NIDEK AFC-230; DR severity per modified Davis staging — 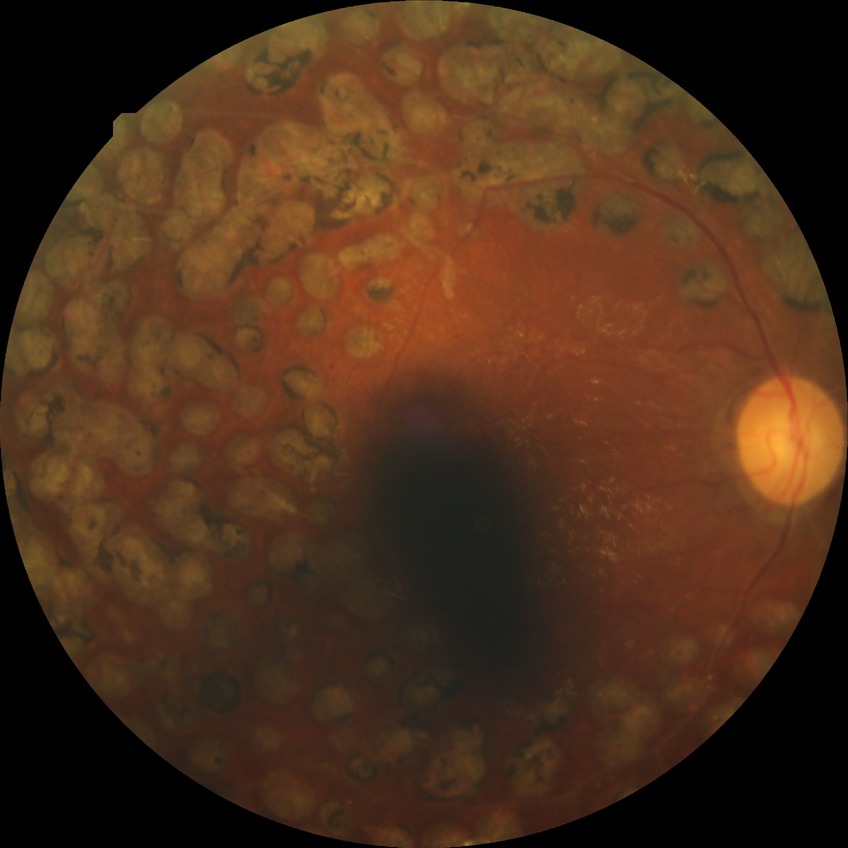
Diabetic retinopathy (DR) is PDR (proliferative diabetic retinopathy).